45° field of view
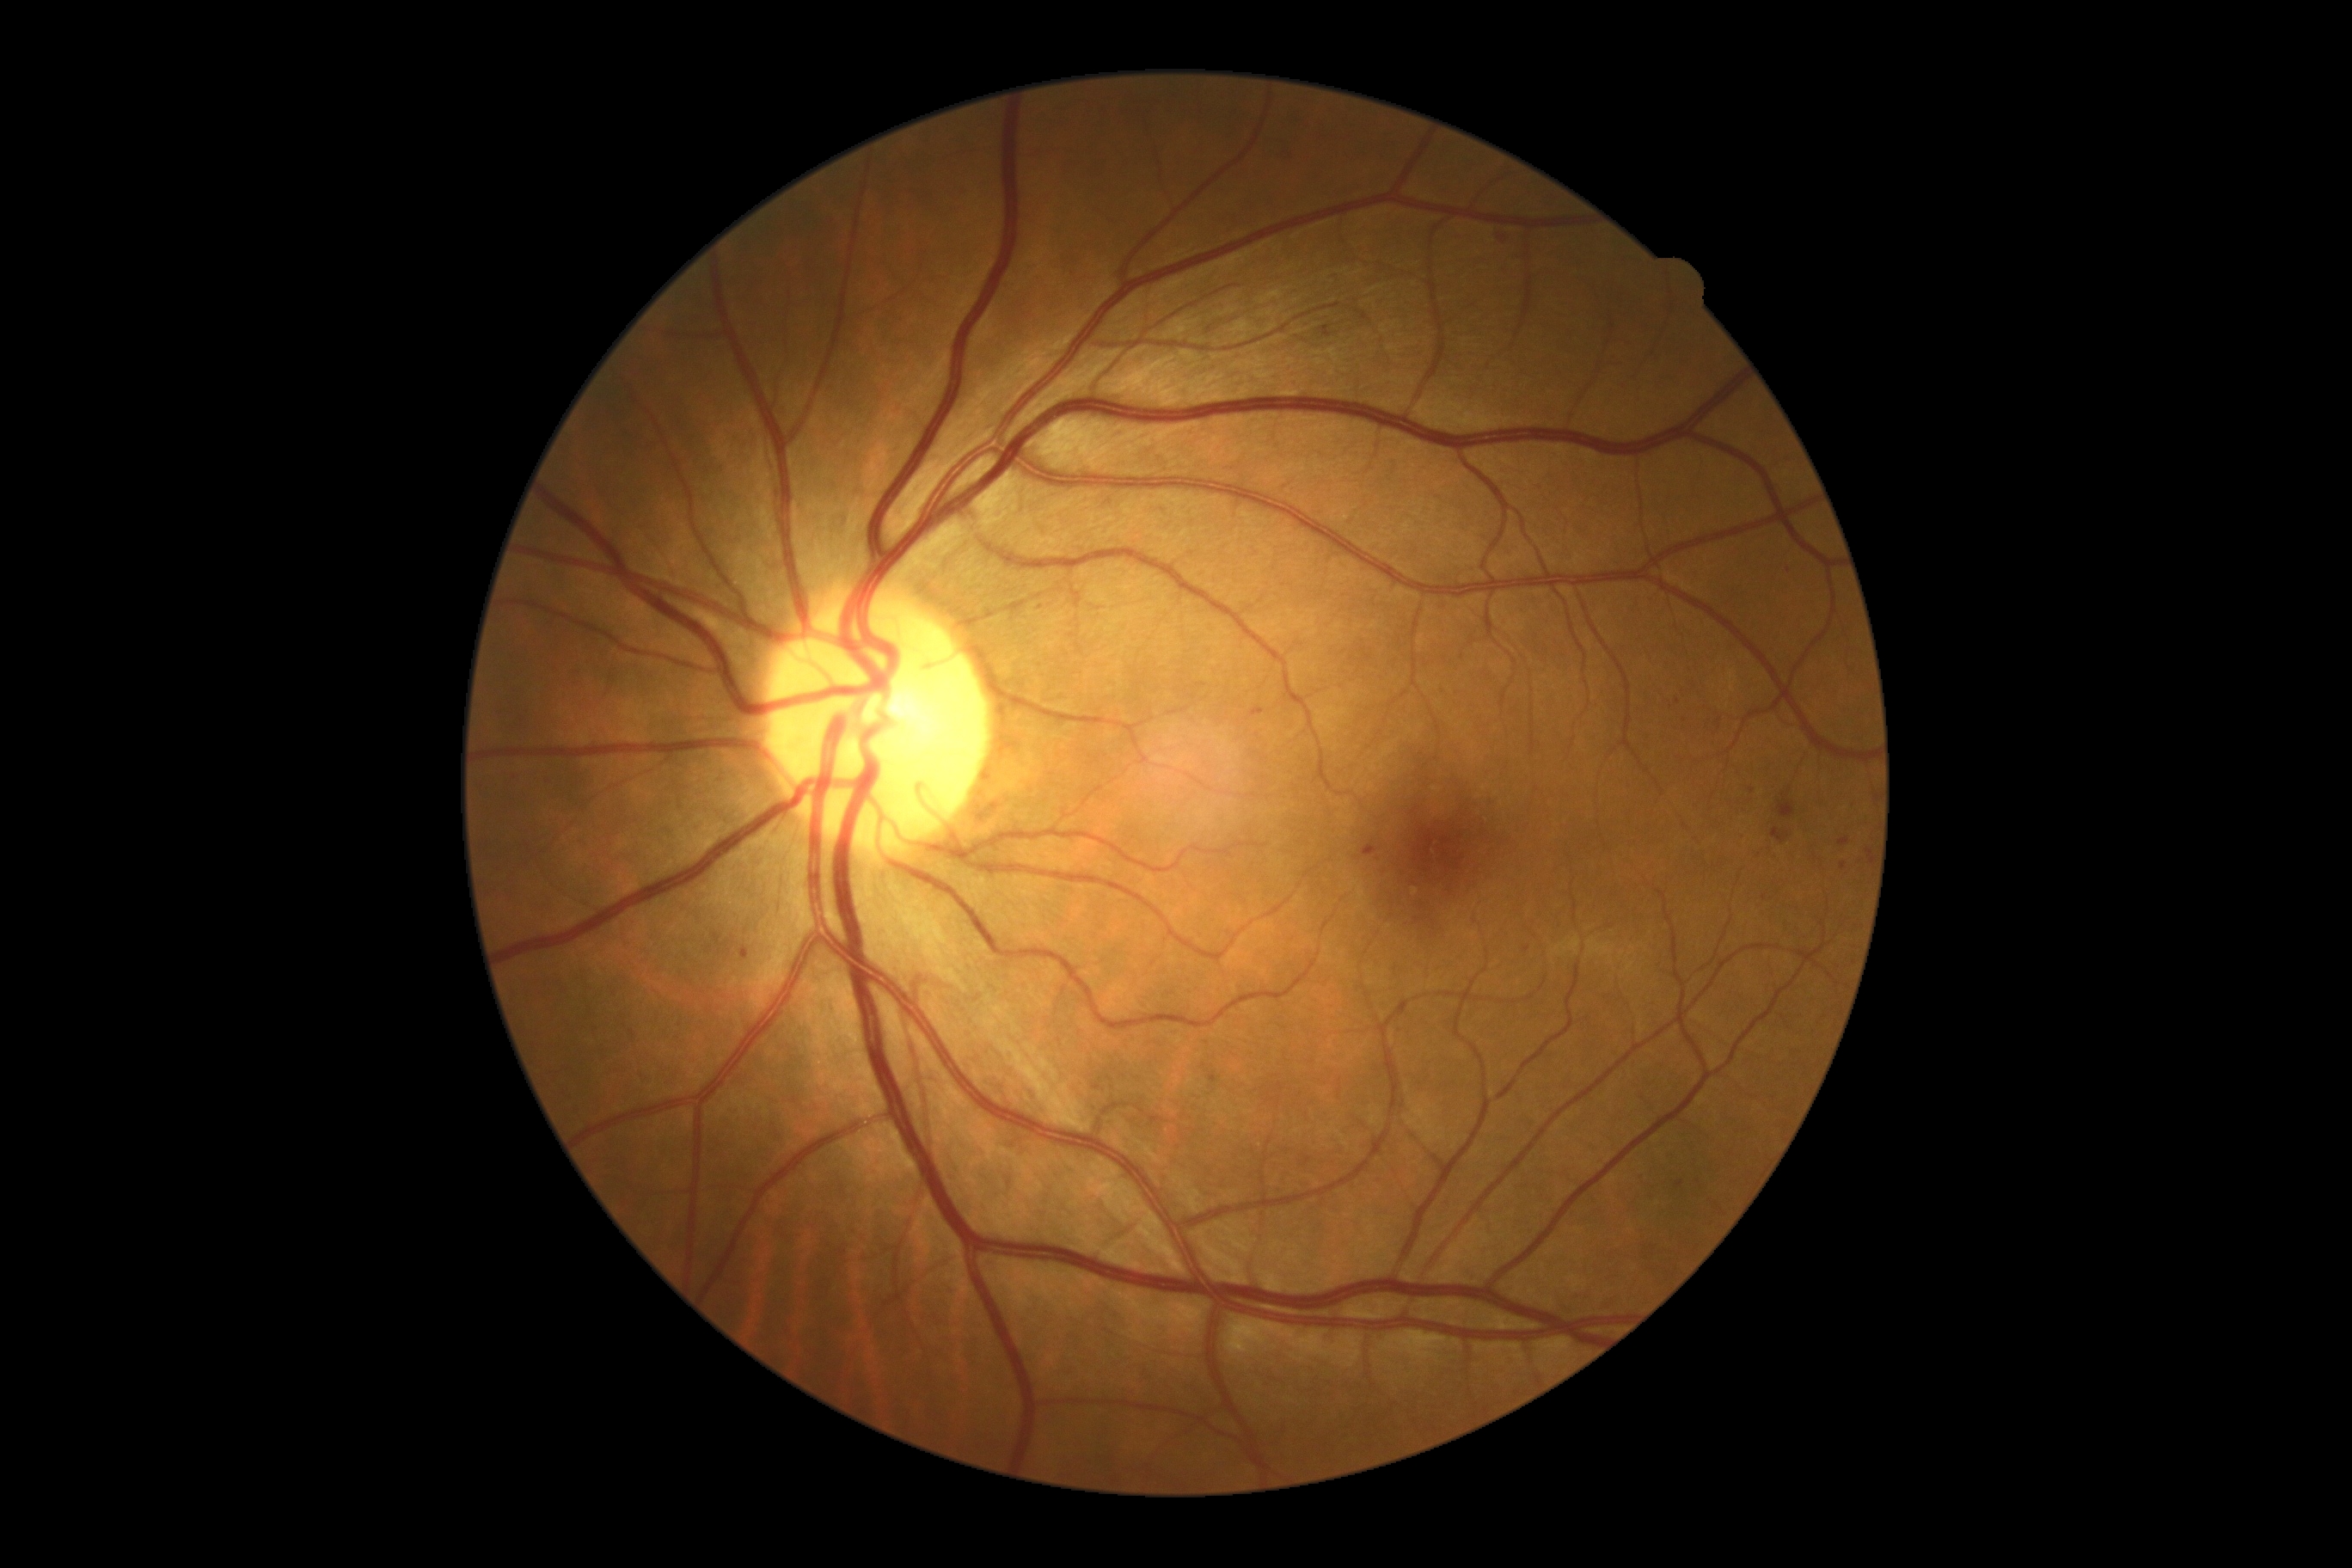

- retinopathy — grade 2 — more than just microaneurysms but less than severe NPDR